45-degree field of view, acquired with a NIDEK AFC-230 — 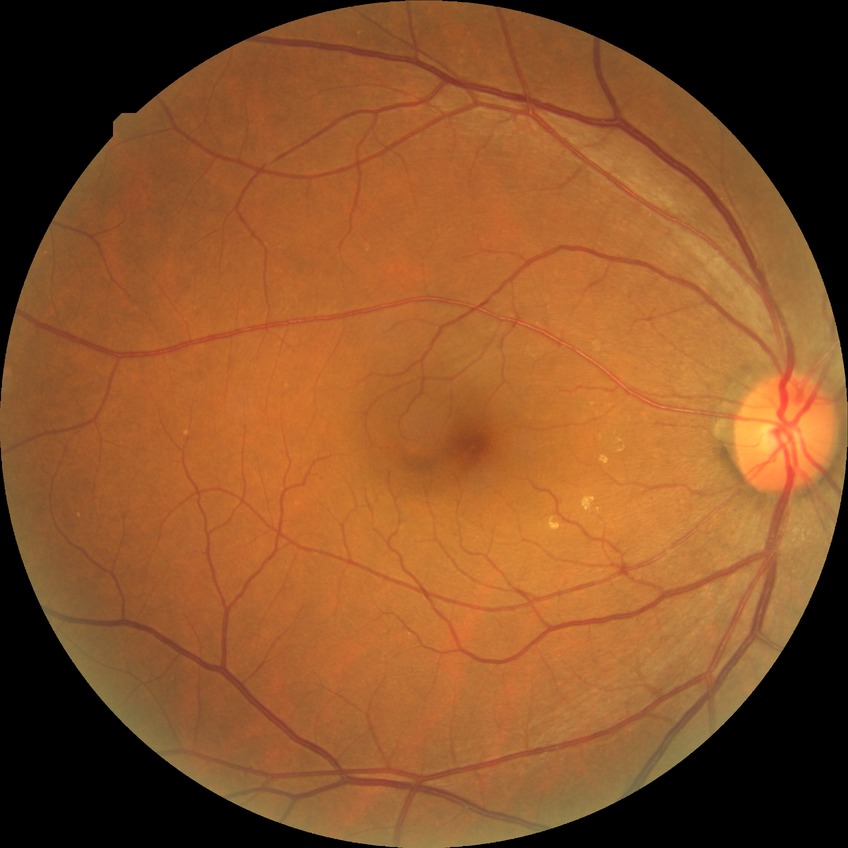 {
  "proliferative_class": "non-proliferative diabetic retinopathy",
  "davis_grade": "SDR"
}